45-degree field of view.
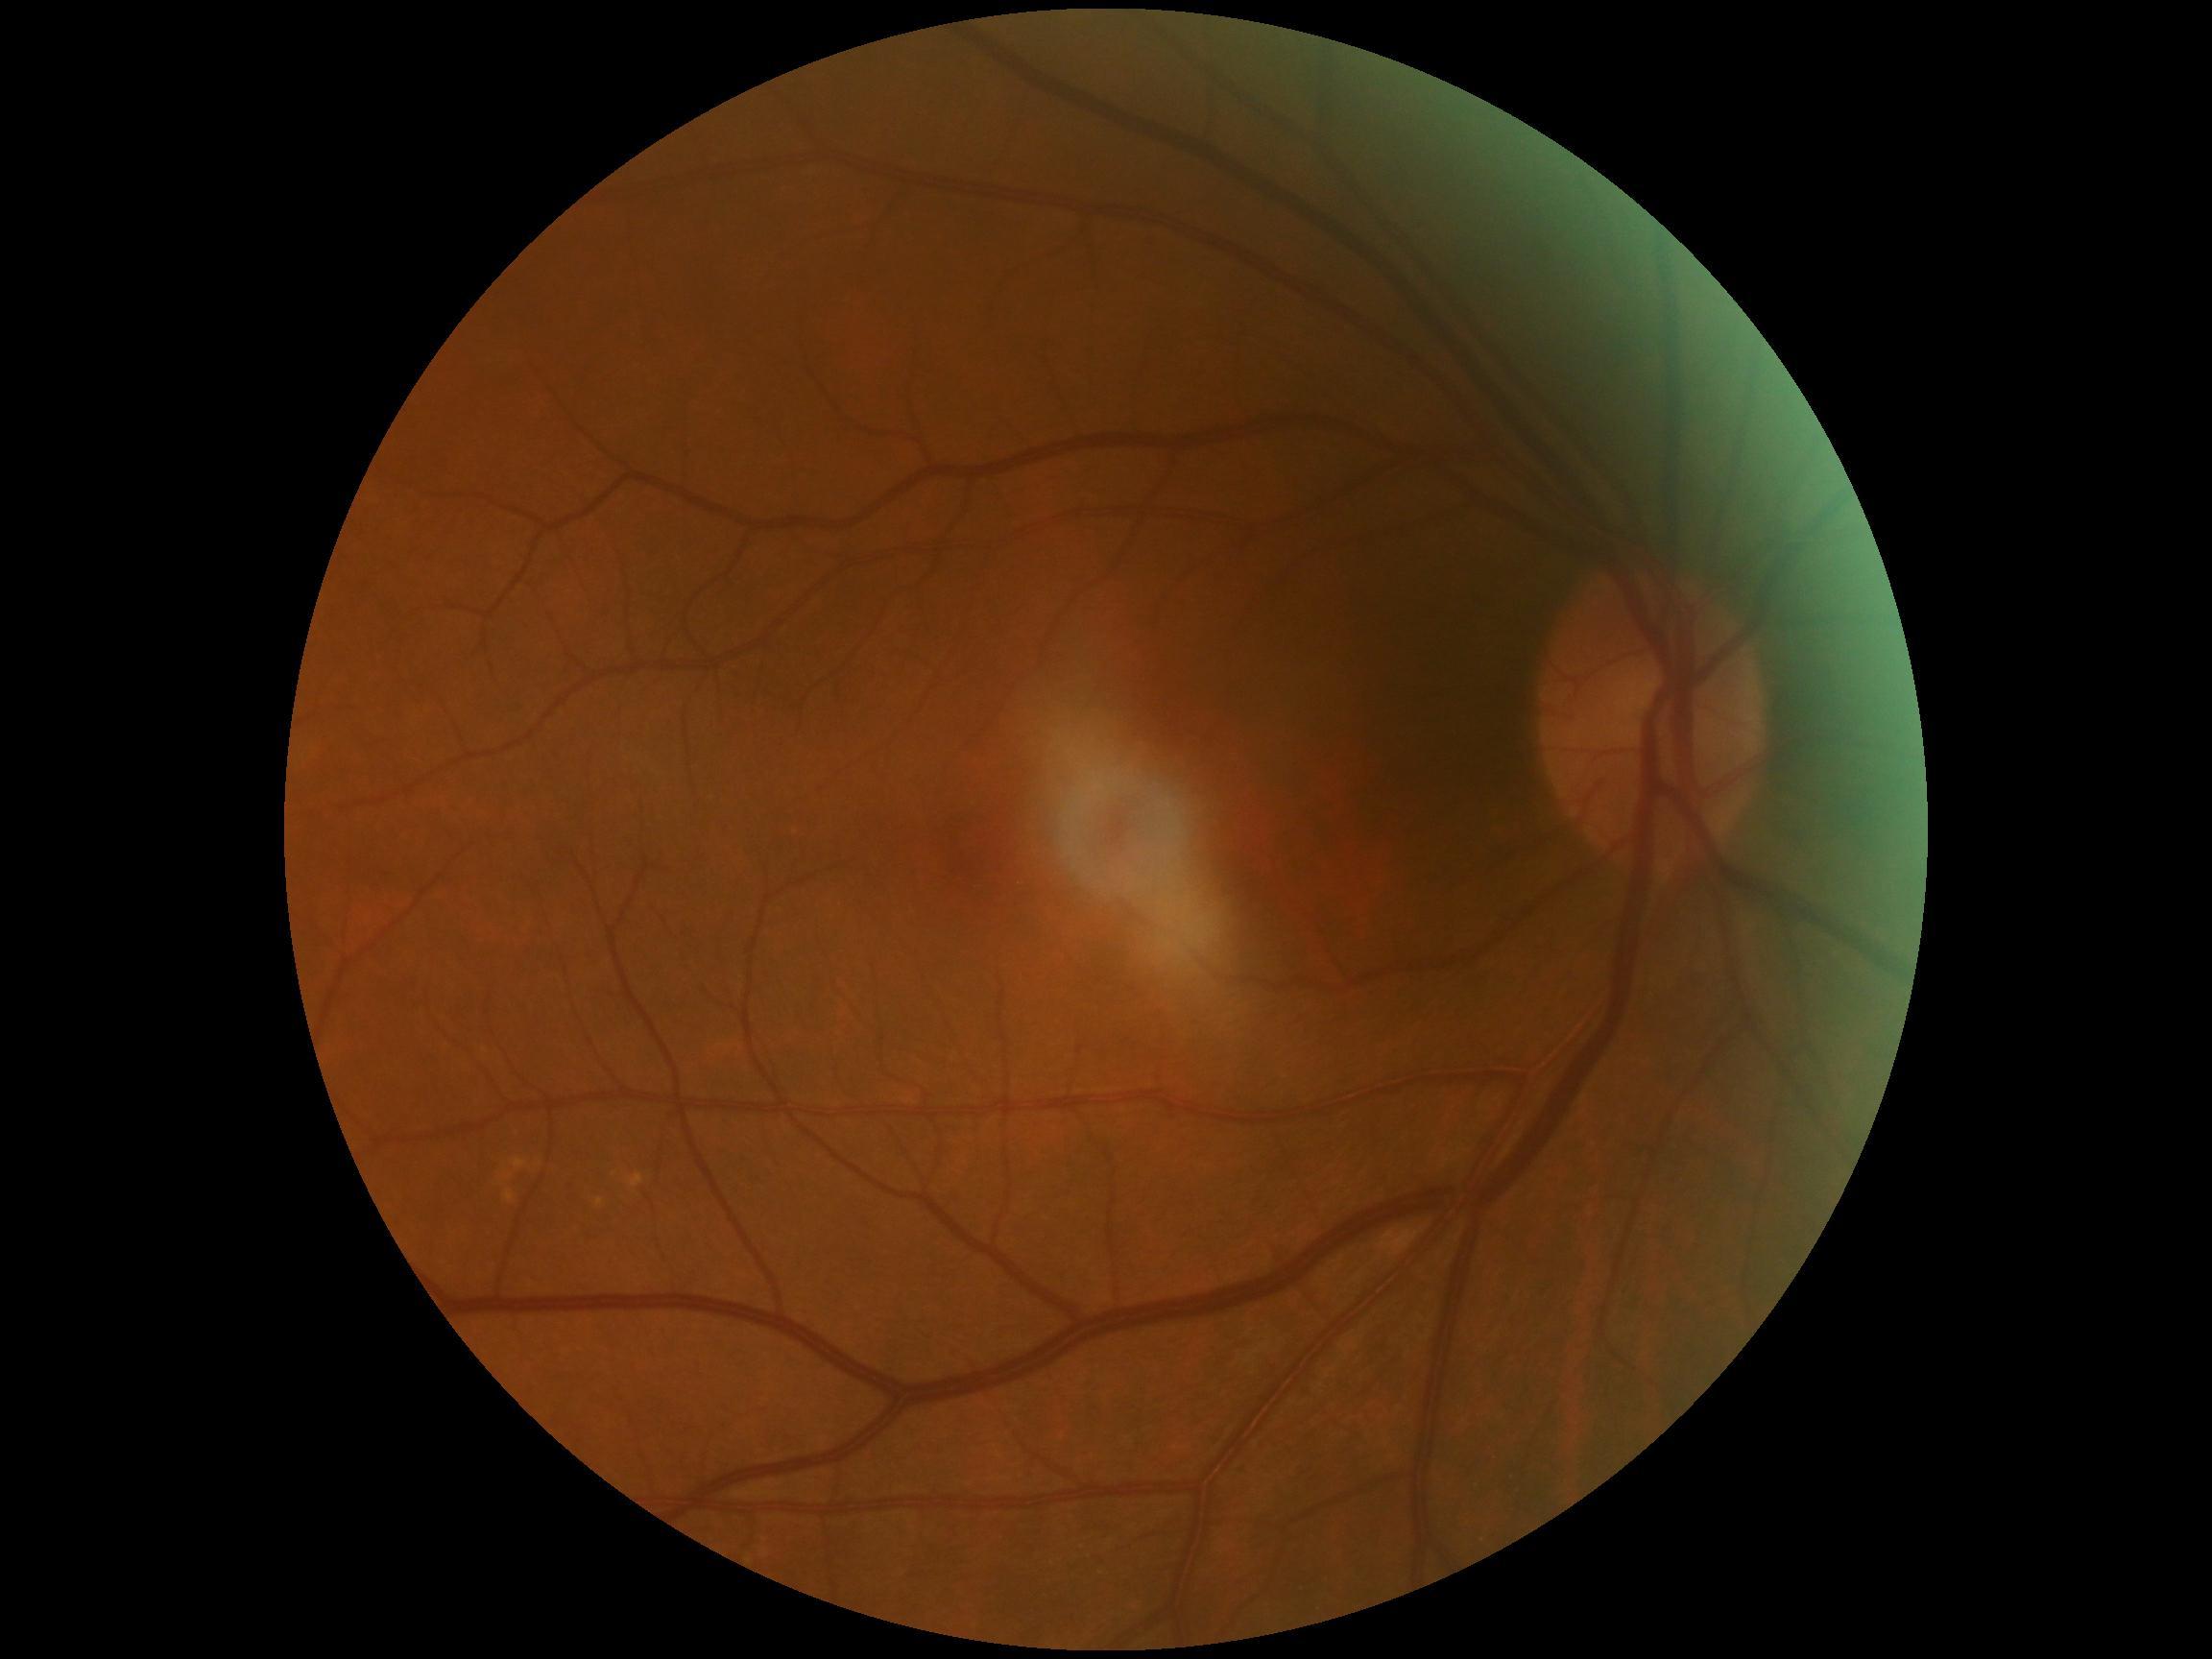 No apparent diabetic retinopathy.
DR severity: 0/4 — no visible signs of diabetic retinopathy.